Camera: NIDEK AFC-230; modified Davis grading; CFP — 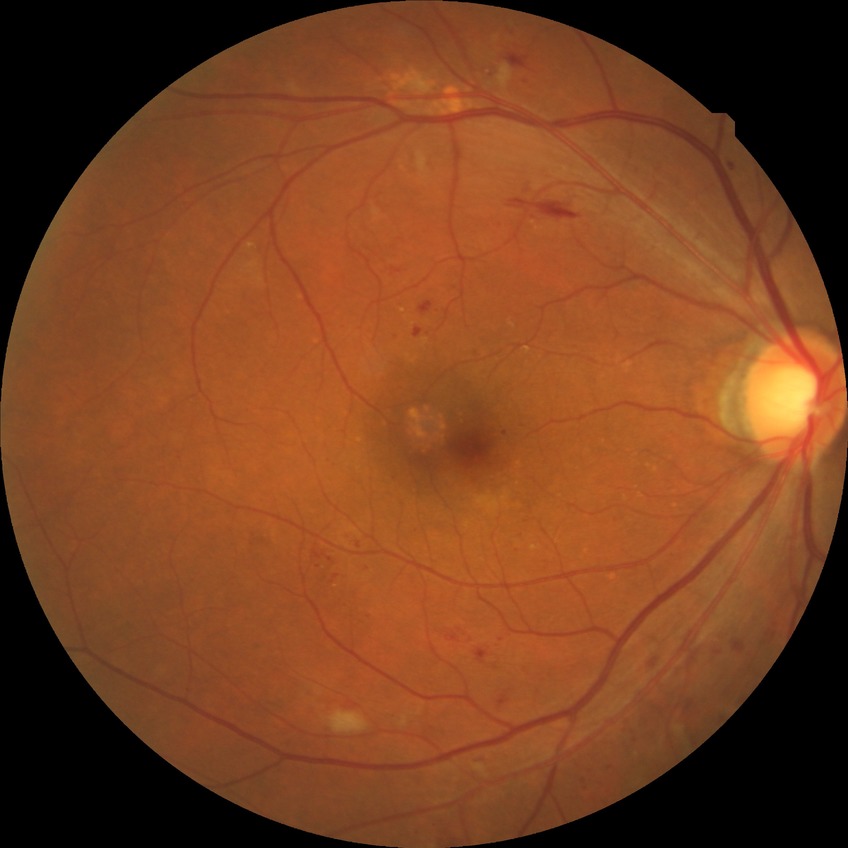
DR severity is PPDR.